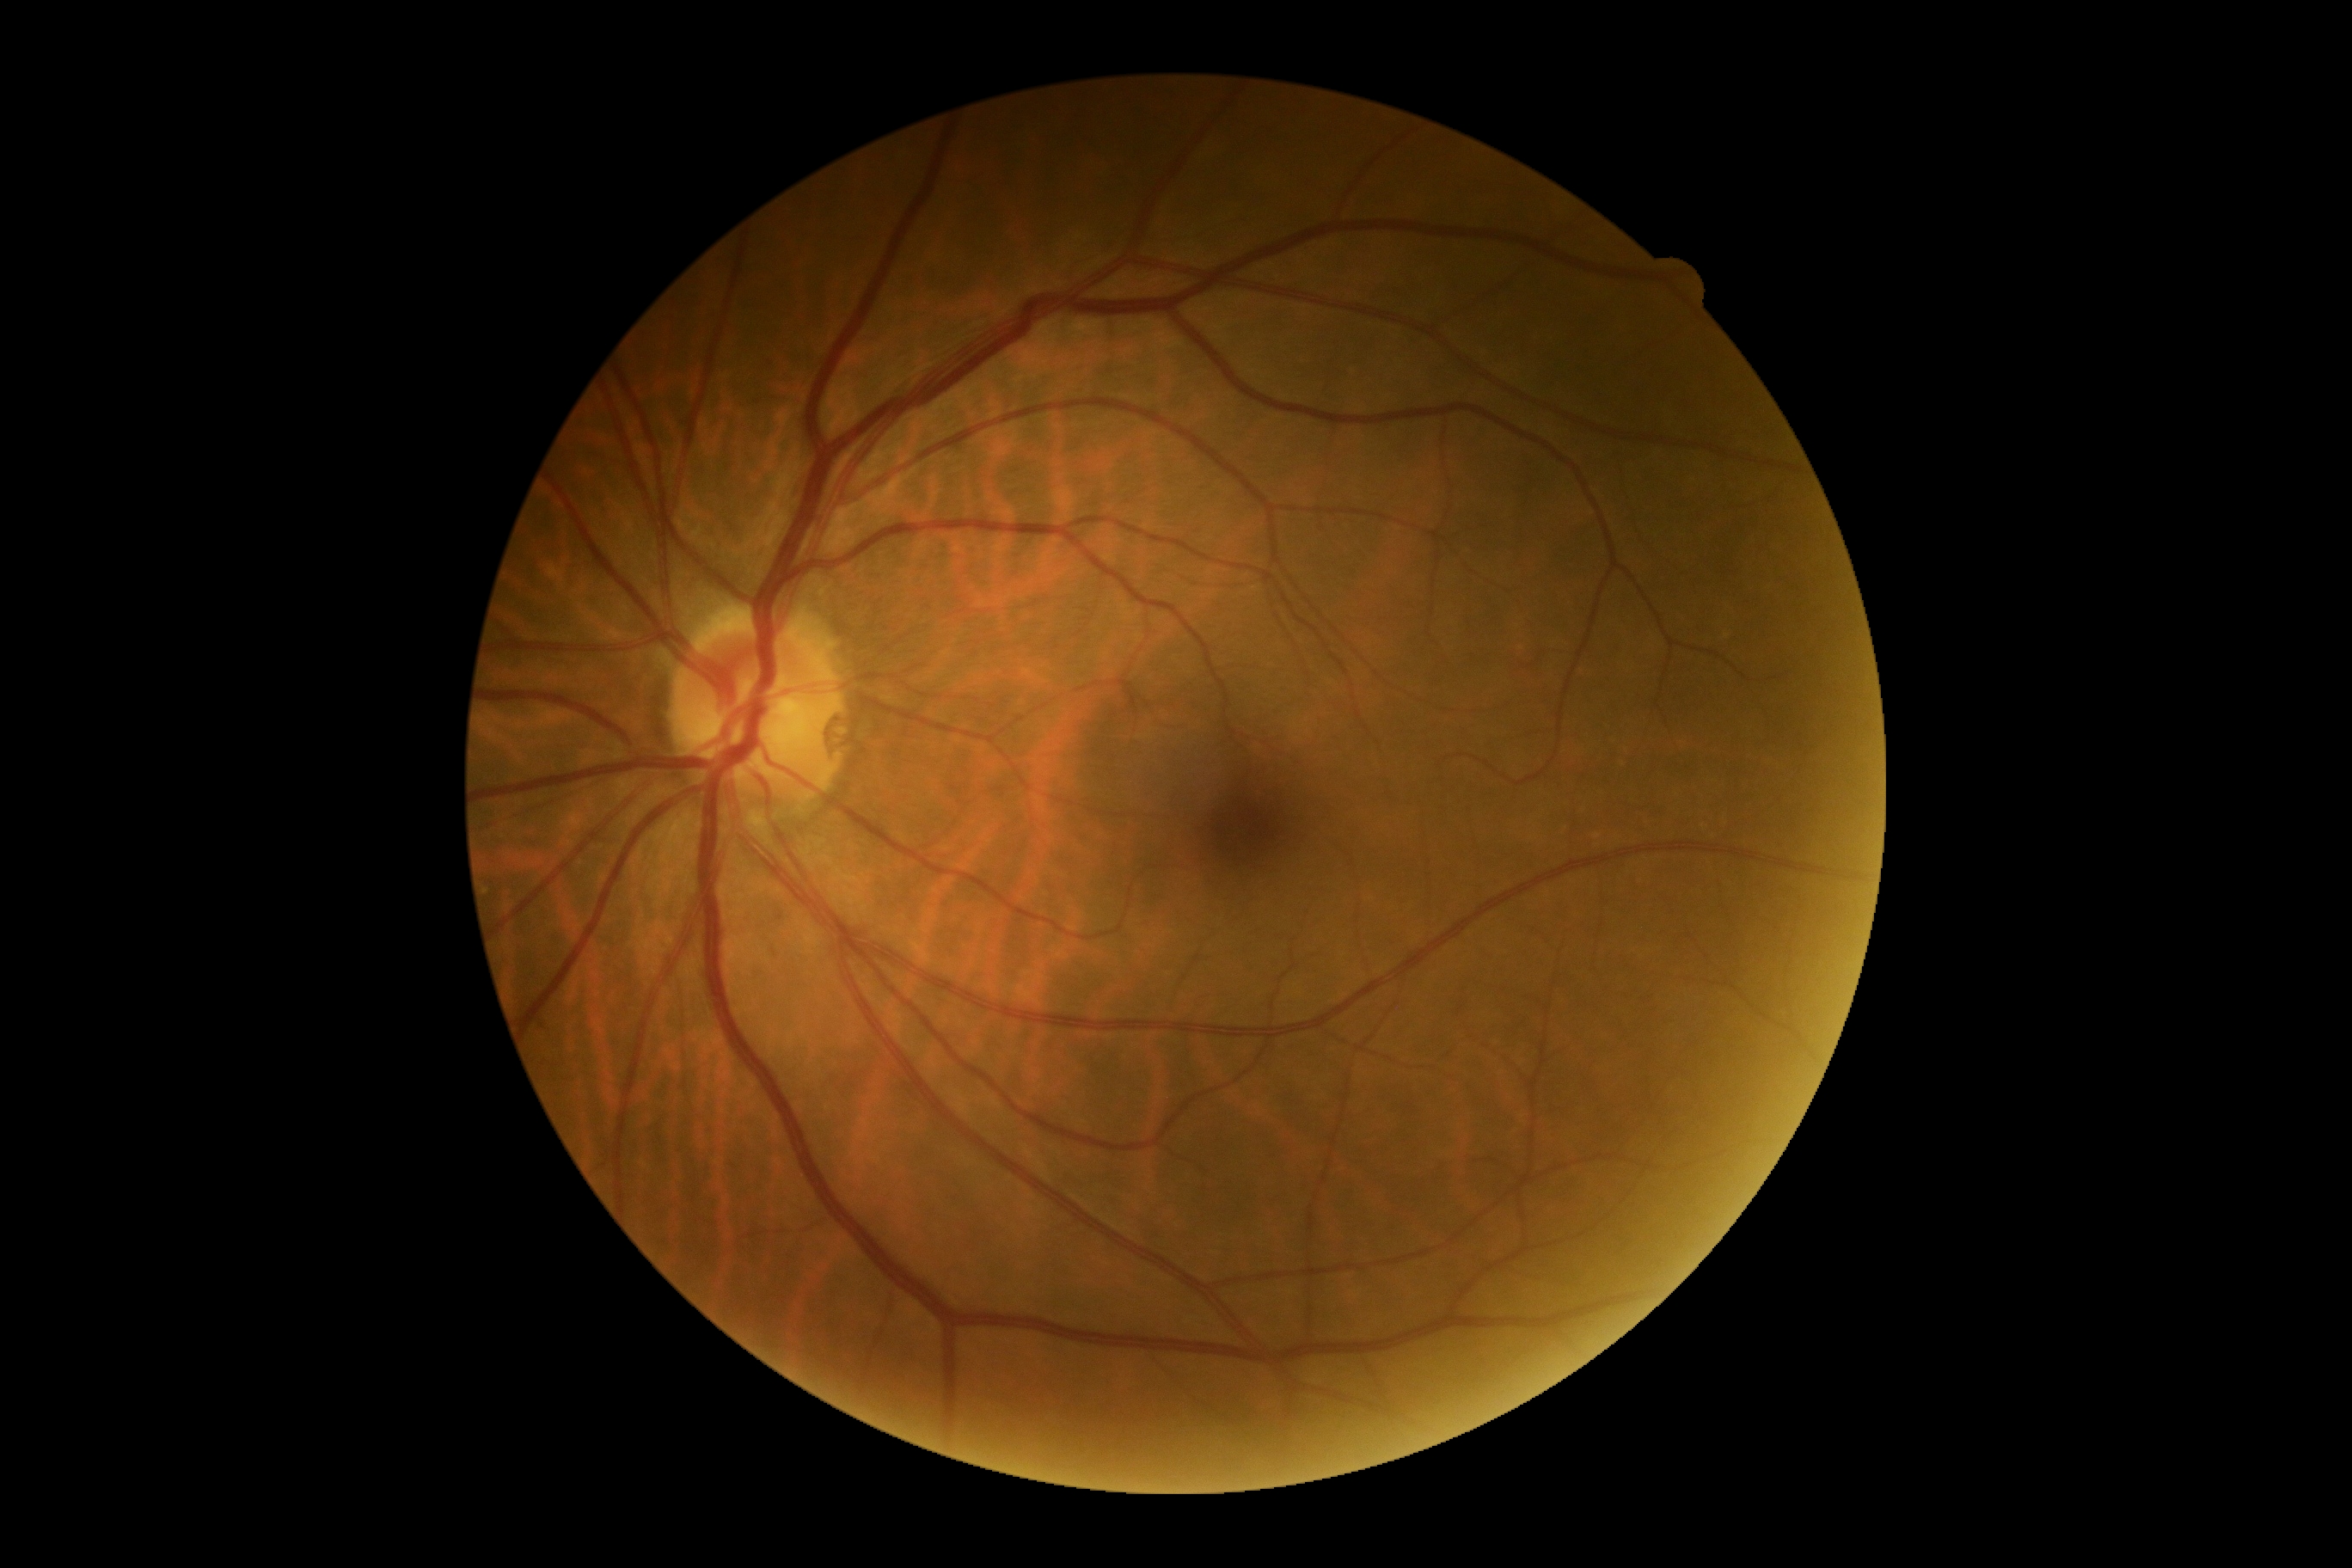

dr_grade: no apparent retinopathy (0)